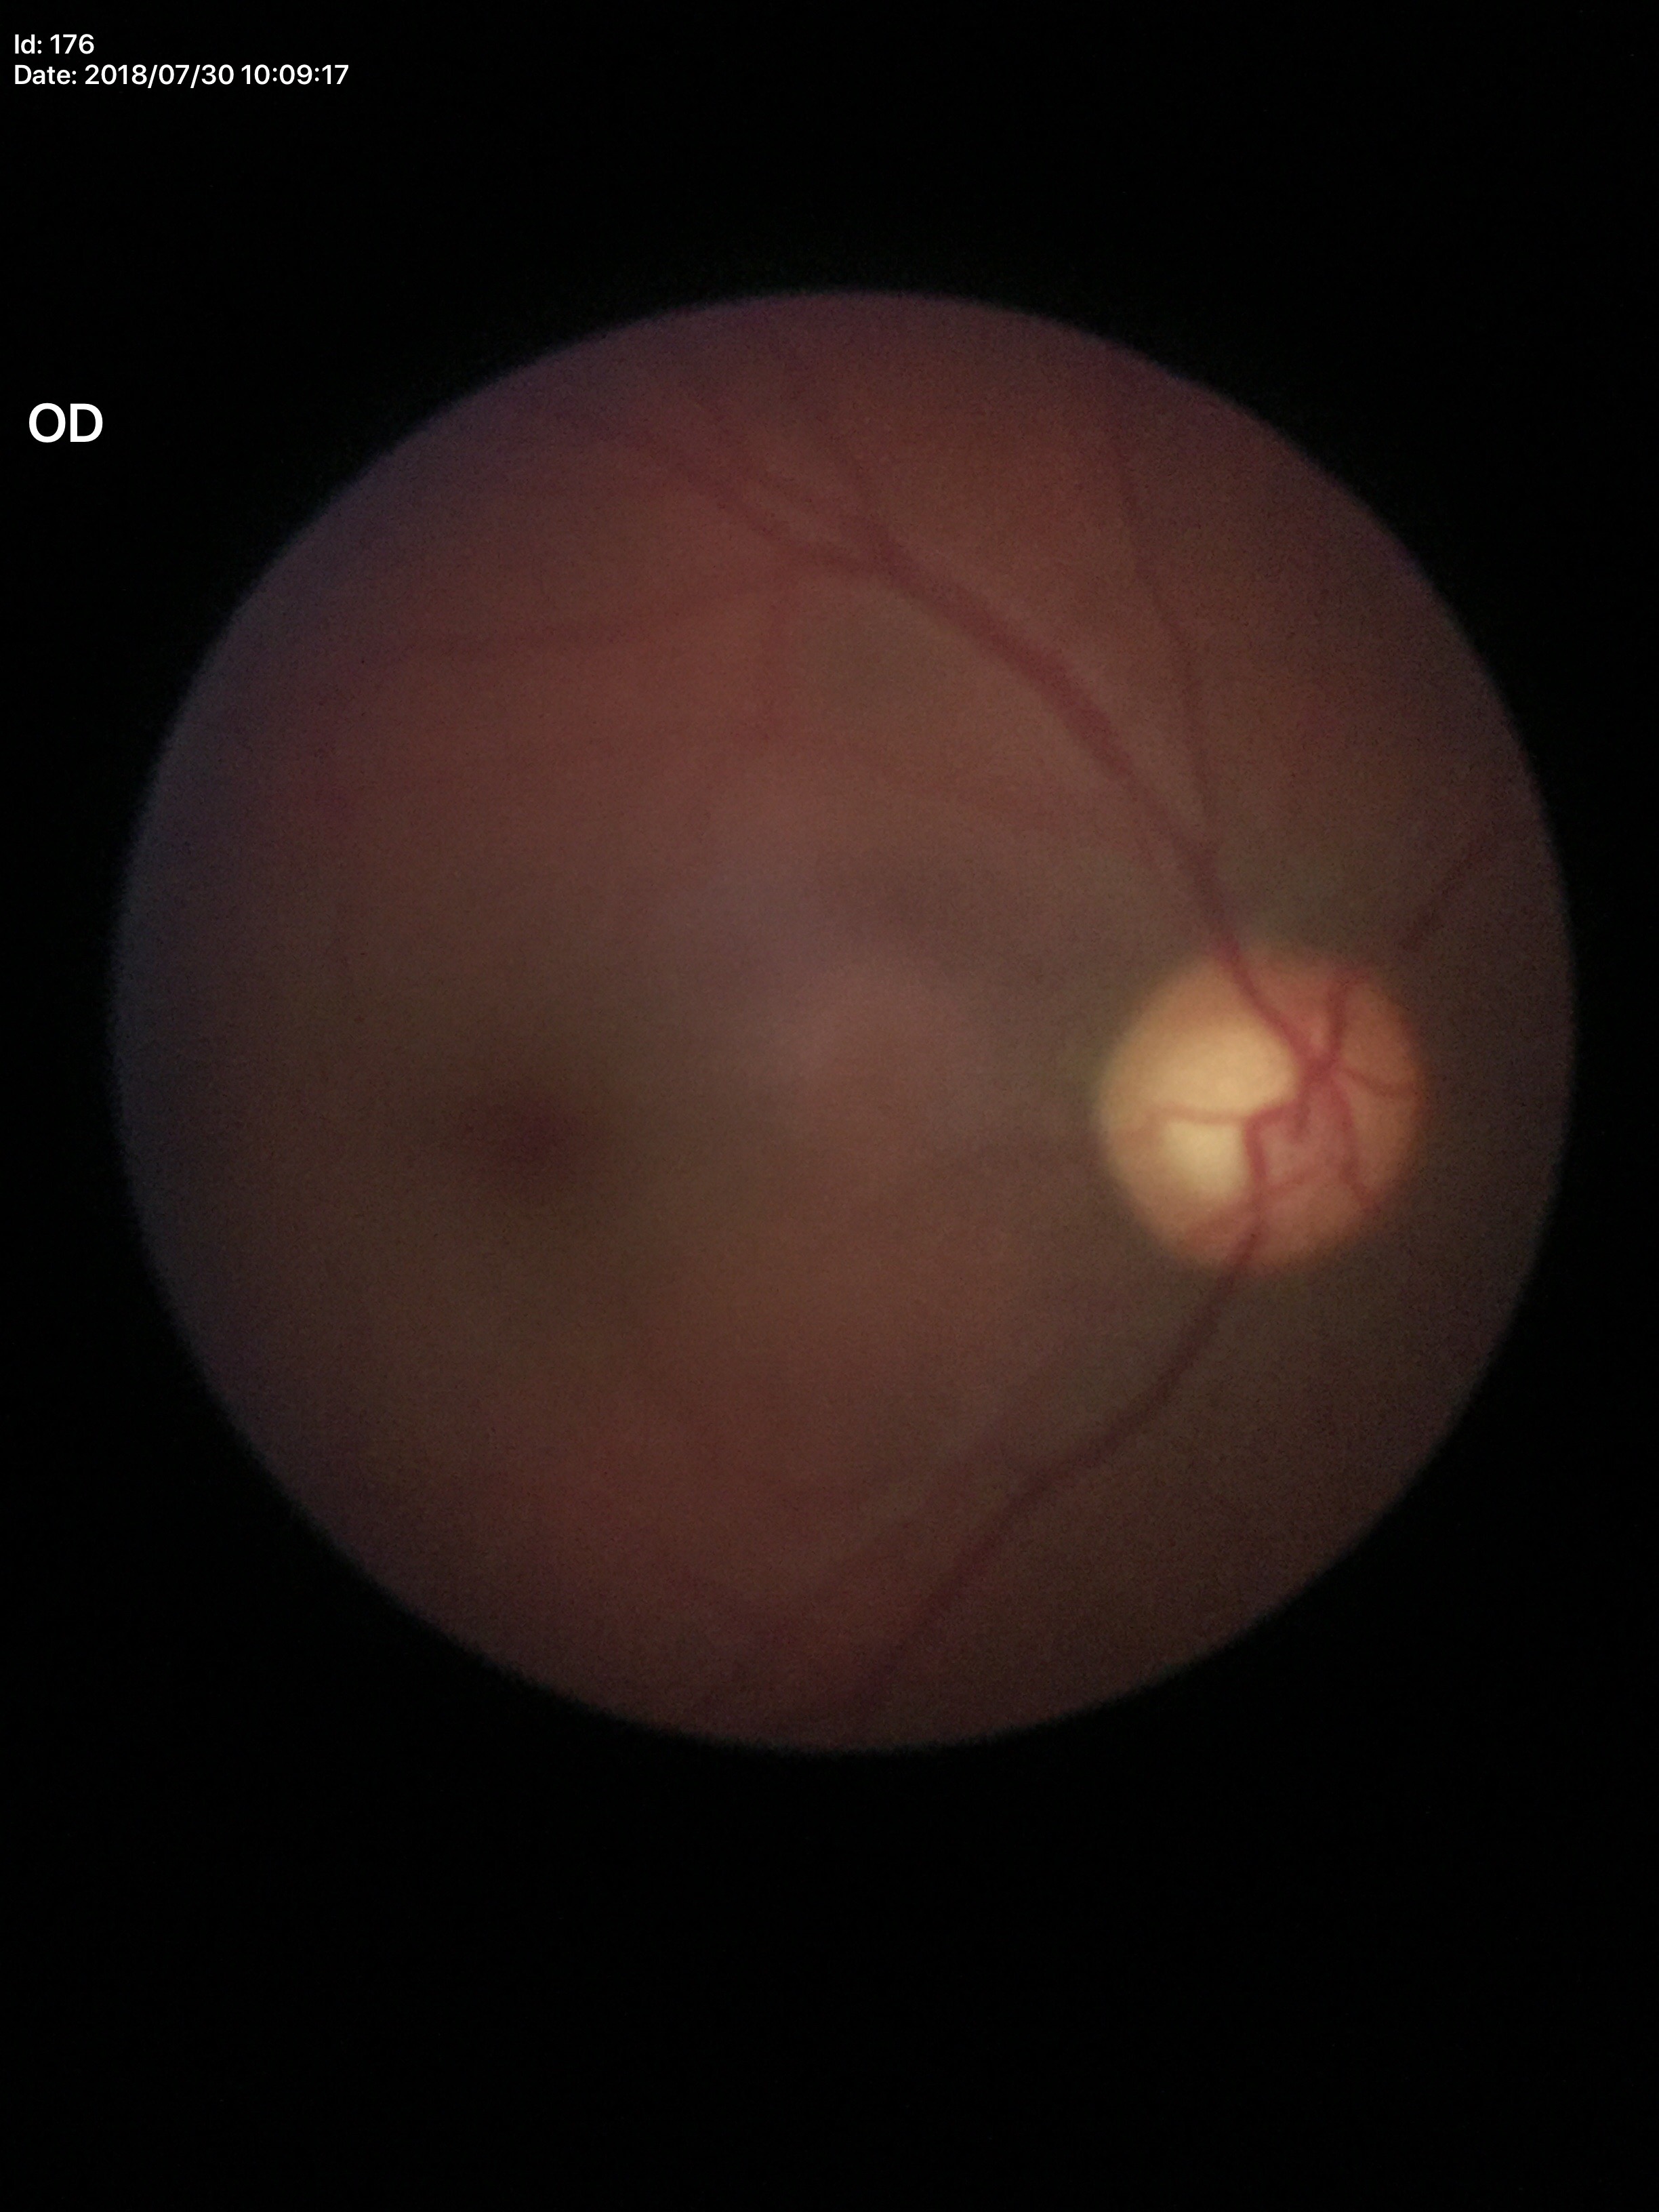
Concerning for glaucoma.
Vertical C/D ratio of 0.63.